FOV: 45 degrees, NIDEK AFC-230, nonmydriatic fundus photograph: 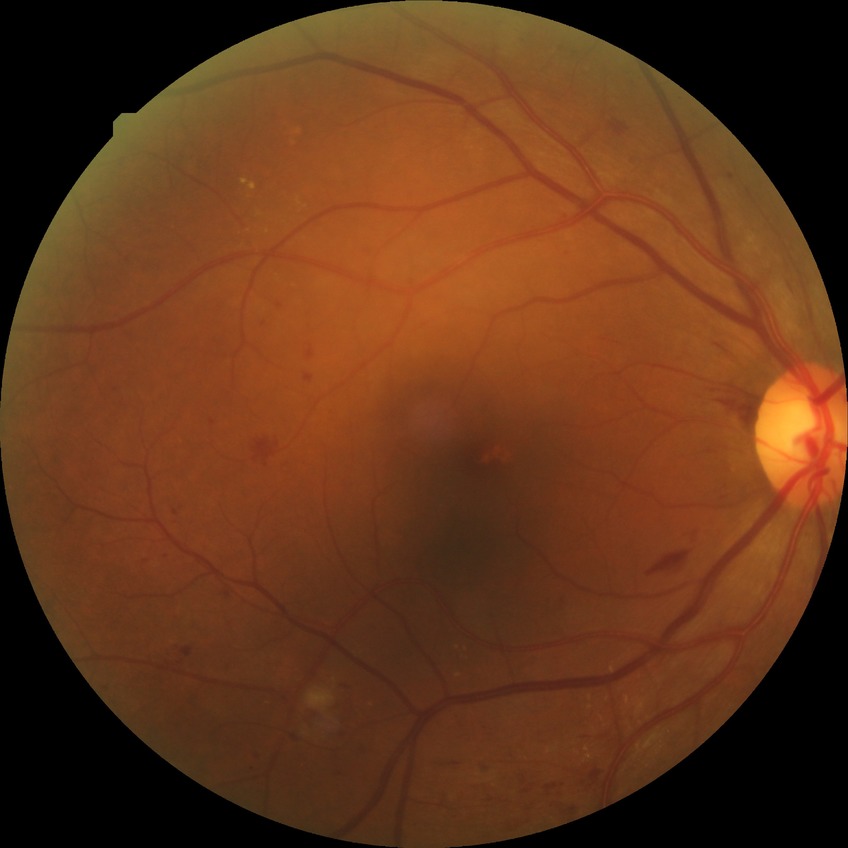
Diabetic retinopathy severity: pre-proliferative diabetic retinopathy. The retinopathy is classified as non-proliferative diabetic retinopathy.